45-degree field of view:
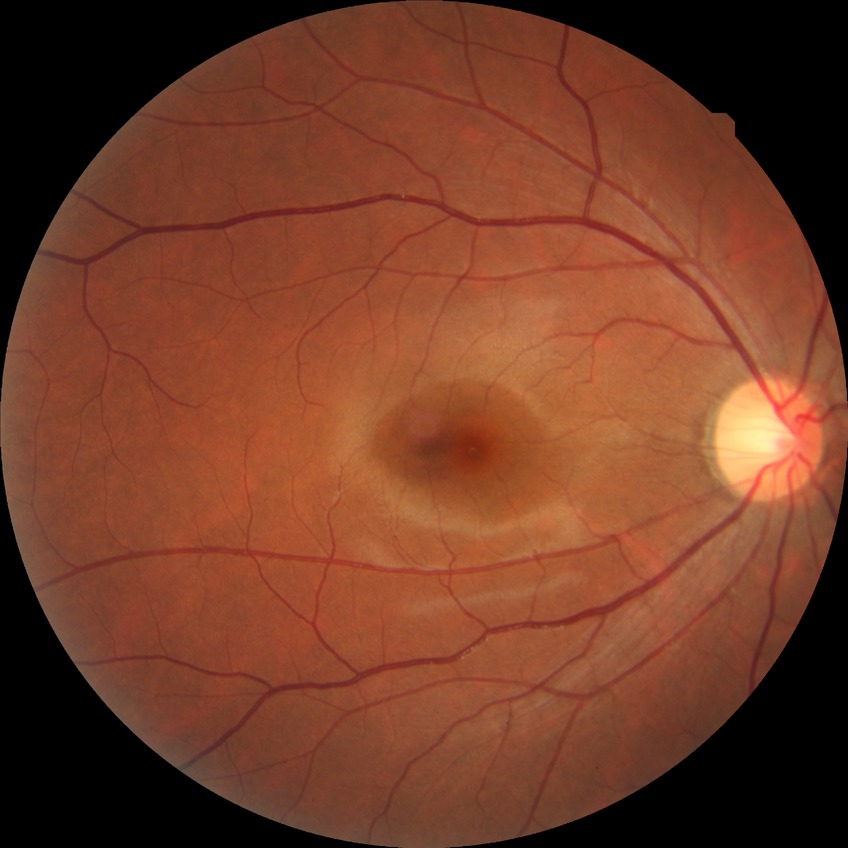 DR class: non-proliferative diabetic retinopathy; diabetic retinopathy (DR): simple diabetic retinopathy (SDR).